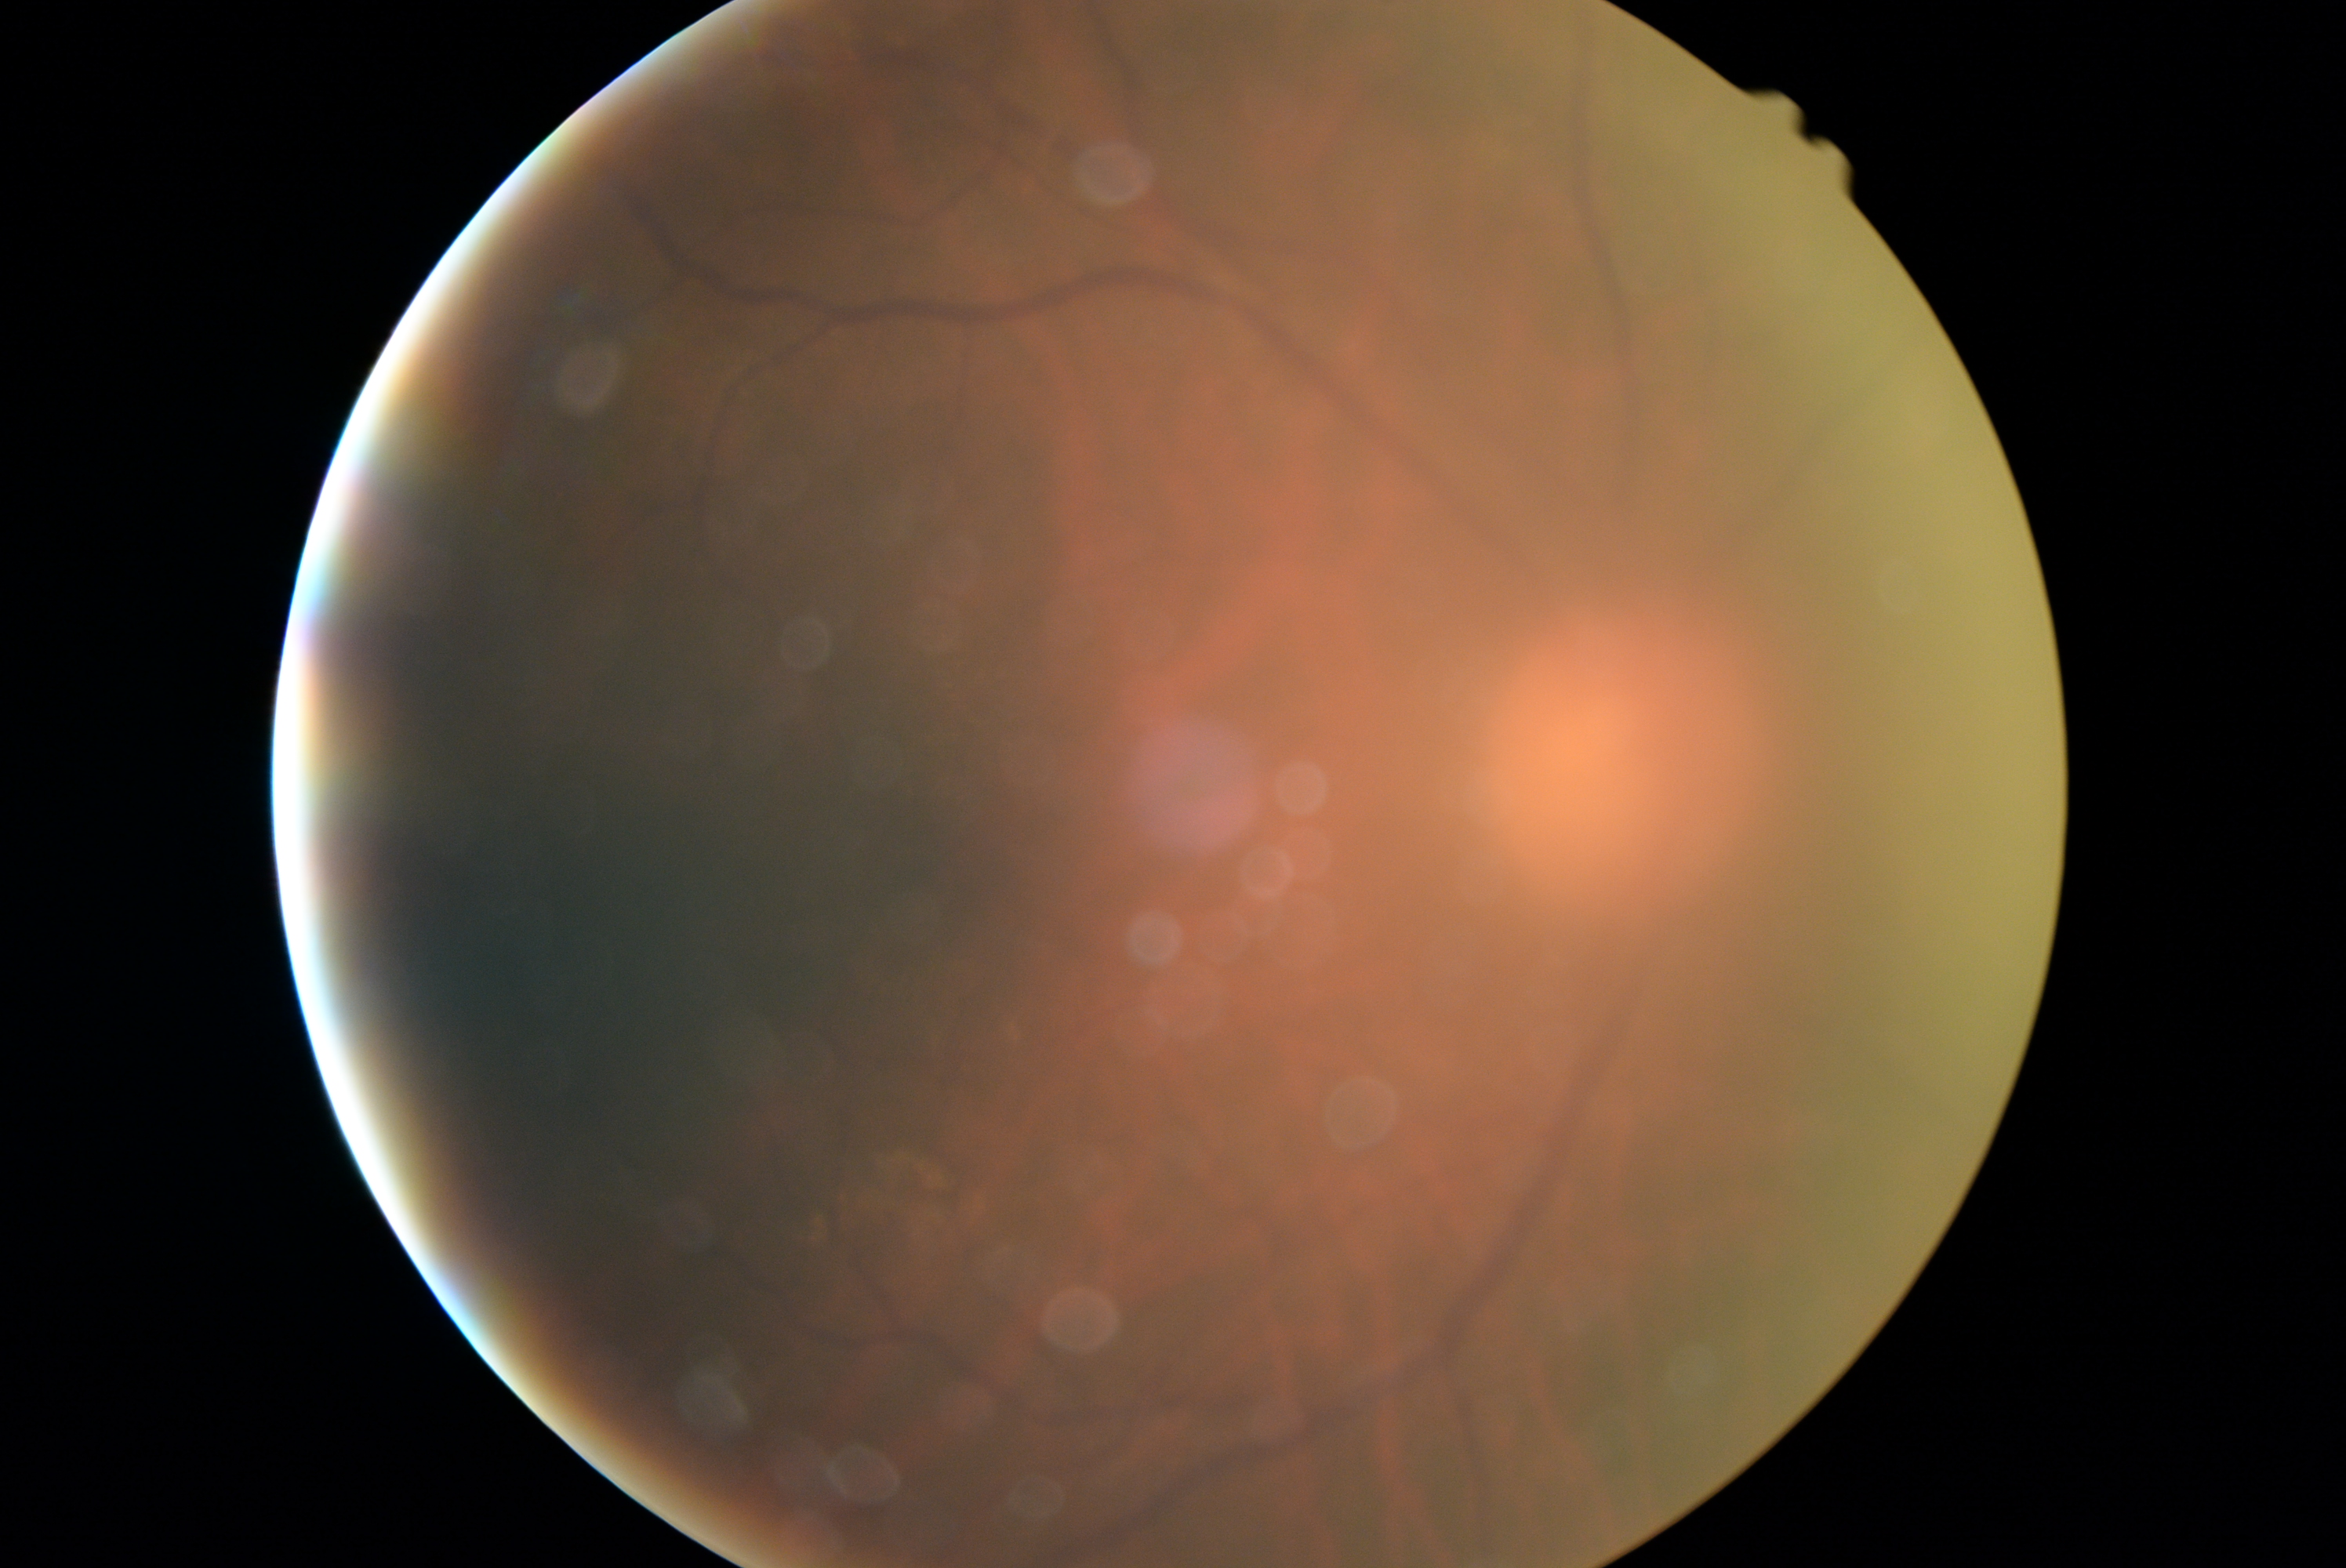
Retinopathy is ungradable.